Color fundus image; 45 degree fundus photograph:
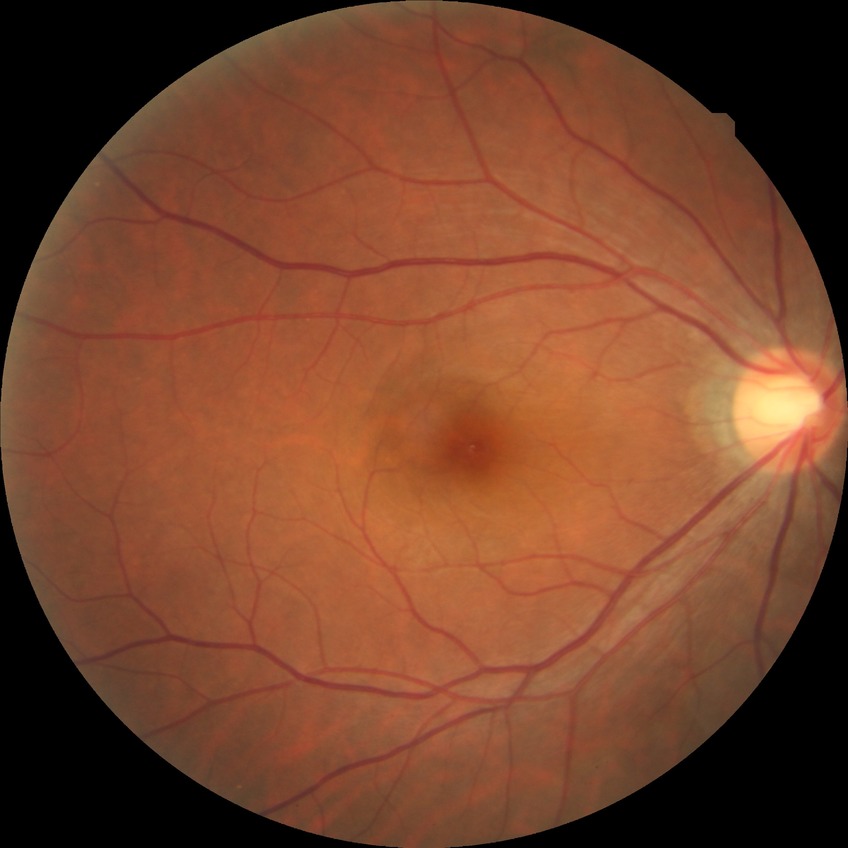

modified Davis classification = no diabetic retinopathy.